Acquired with a NIDEK AFC-230.
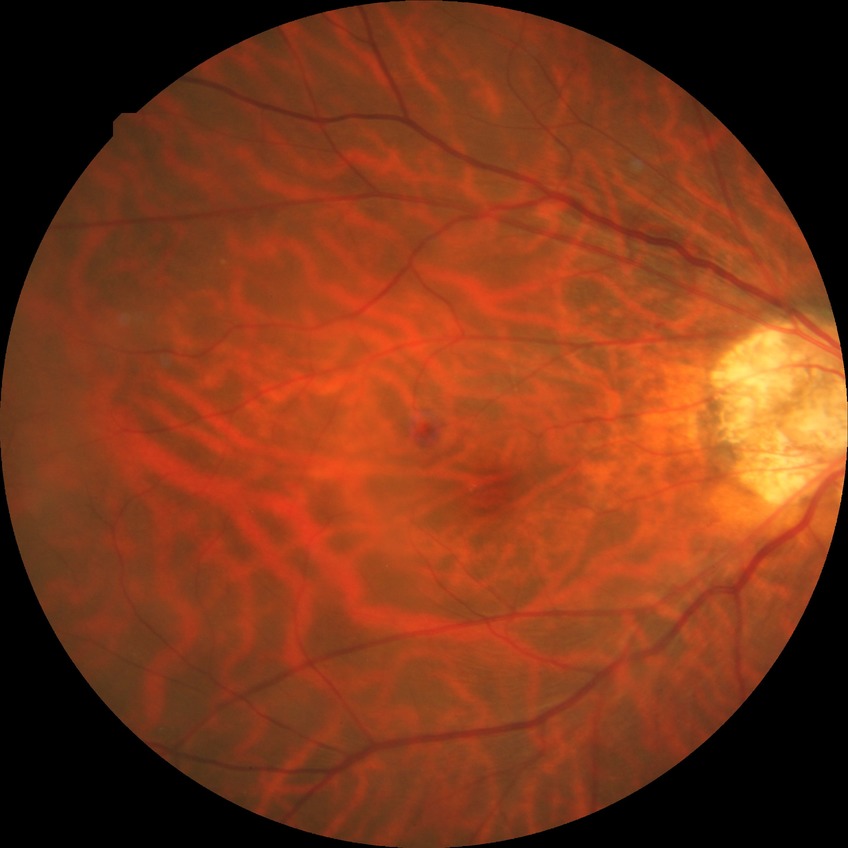 - diabetic retinopathy (DR) — NDR (no diabetic retinopathy)